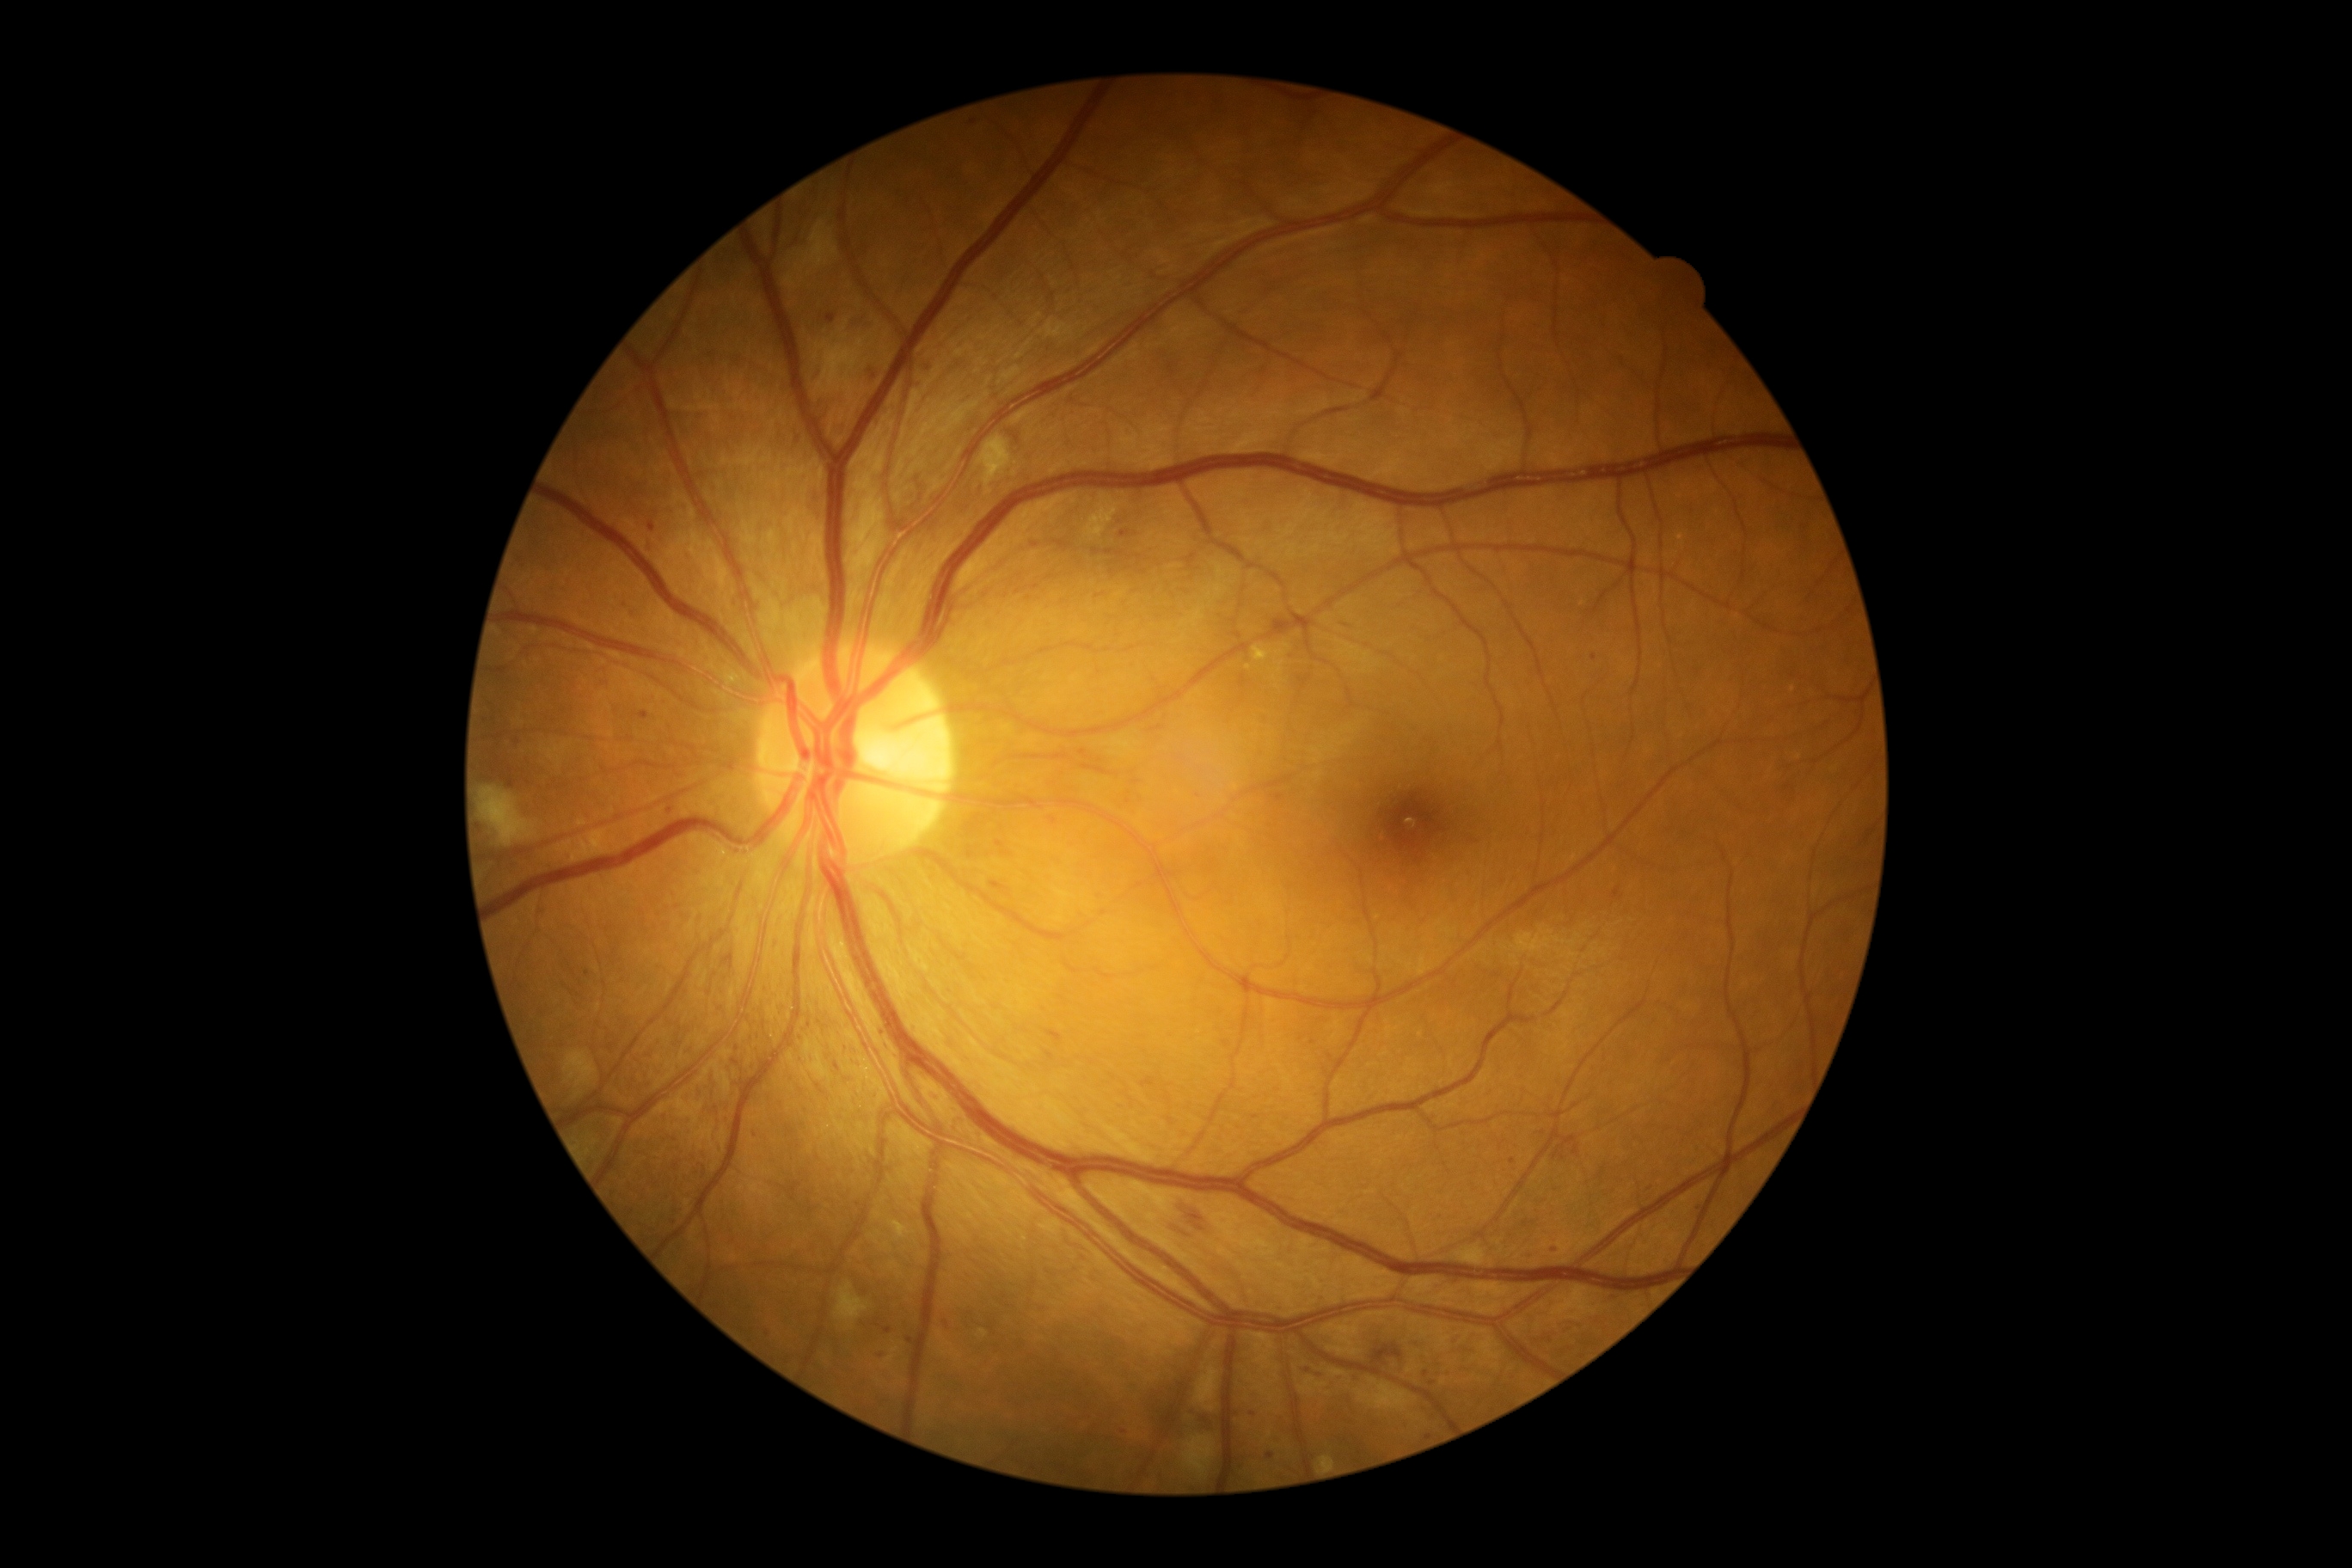

DR stage is 2 — more than just microaneurysms but less than severe NPDR.